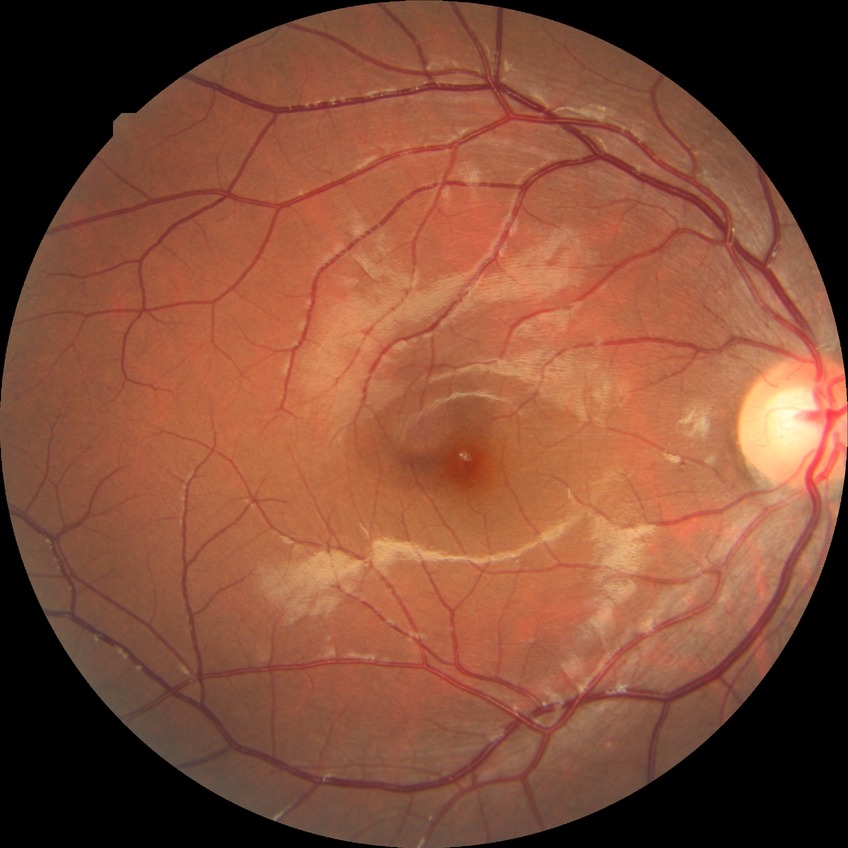

diabetic retinopathy (DR)=NDR (no diabetic retinopathy).